Image size 640x480 · pediatric retinal photograph (wide-field) — 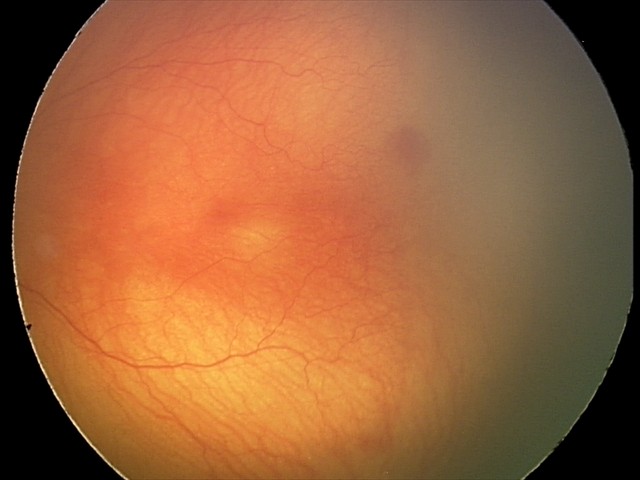 Q: What is the plus-form classification?
A: plus disease
Q: What is the screening diagnosis?
A: aggressive retinopathy of prematurity (A-ROP)